Non-mydriatic acquisition:
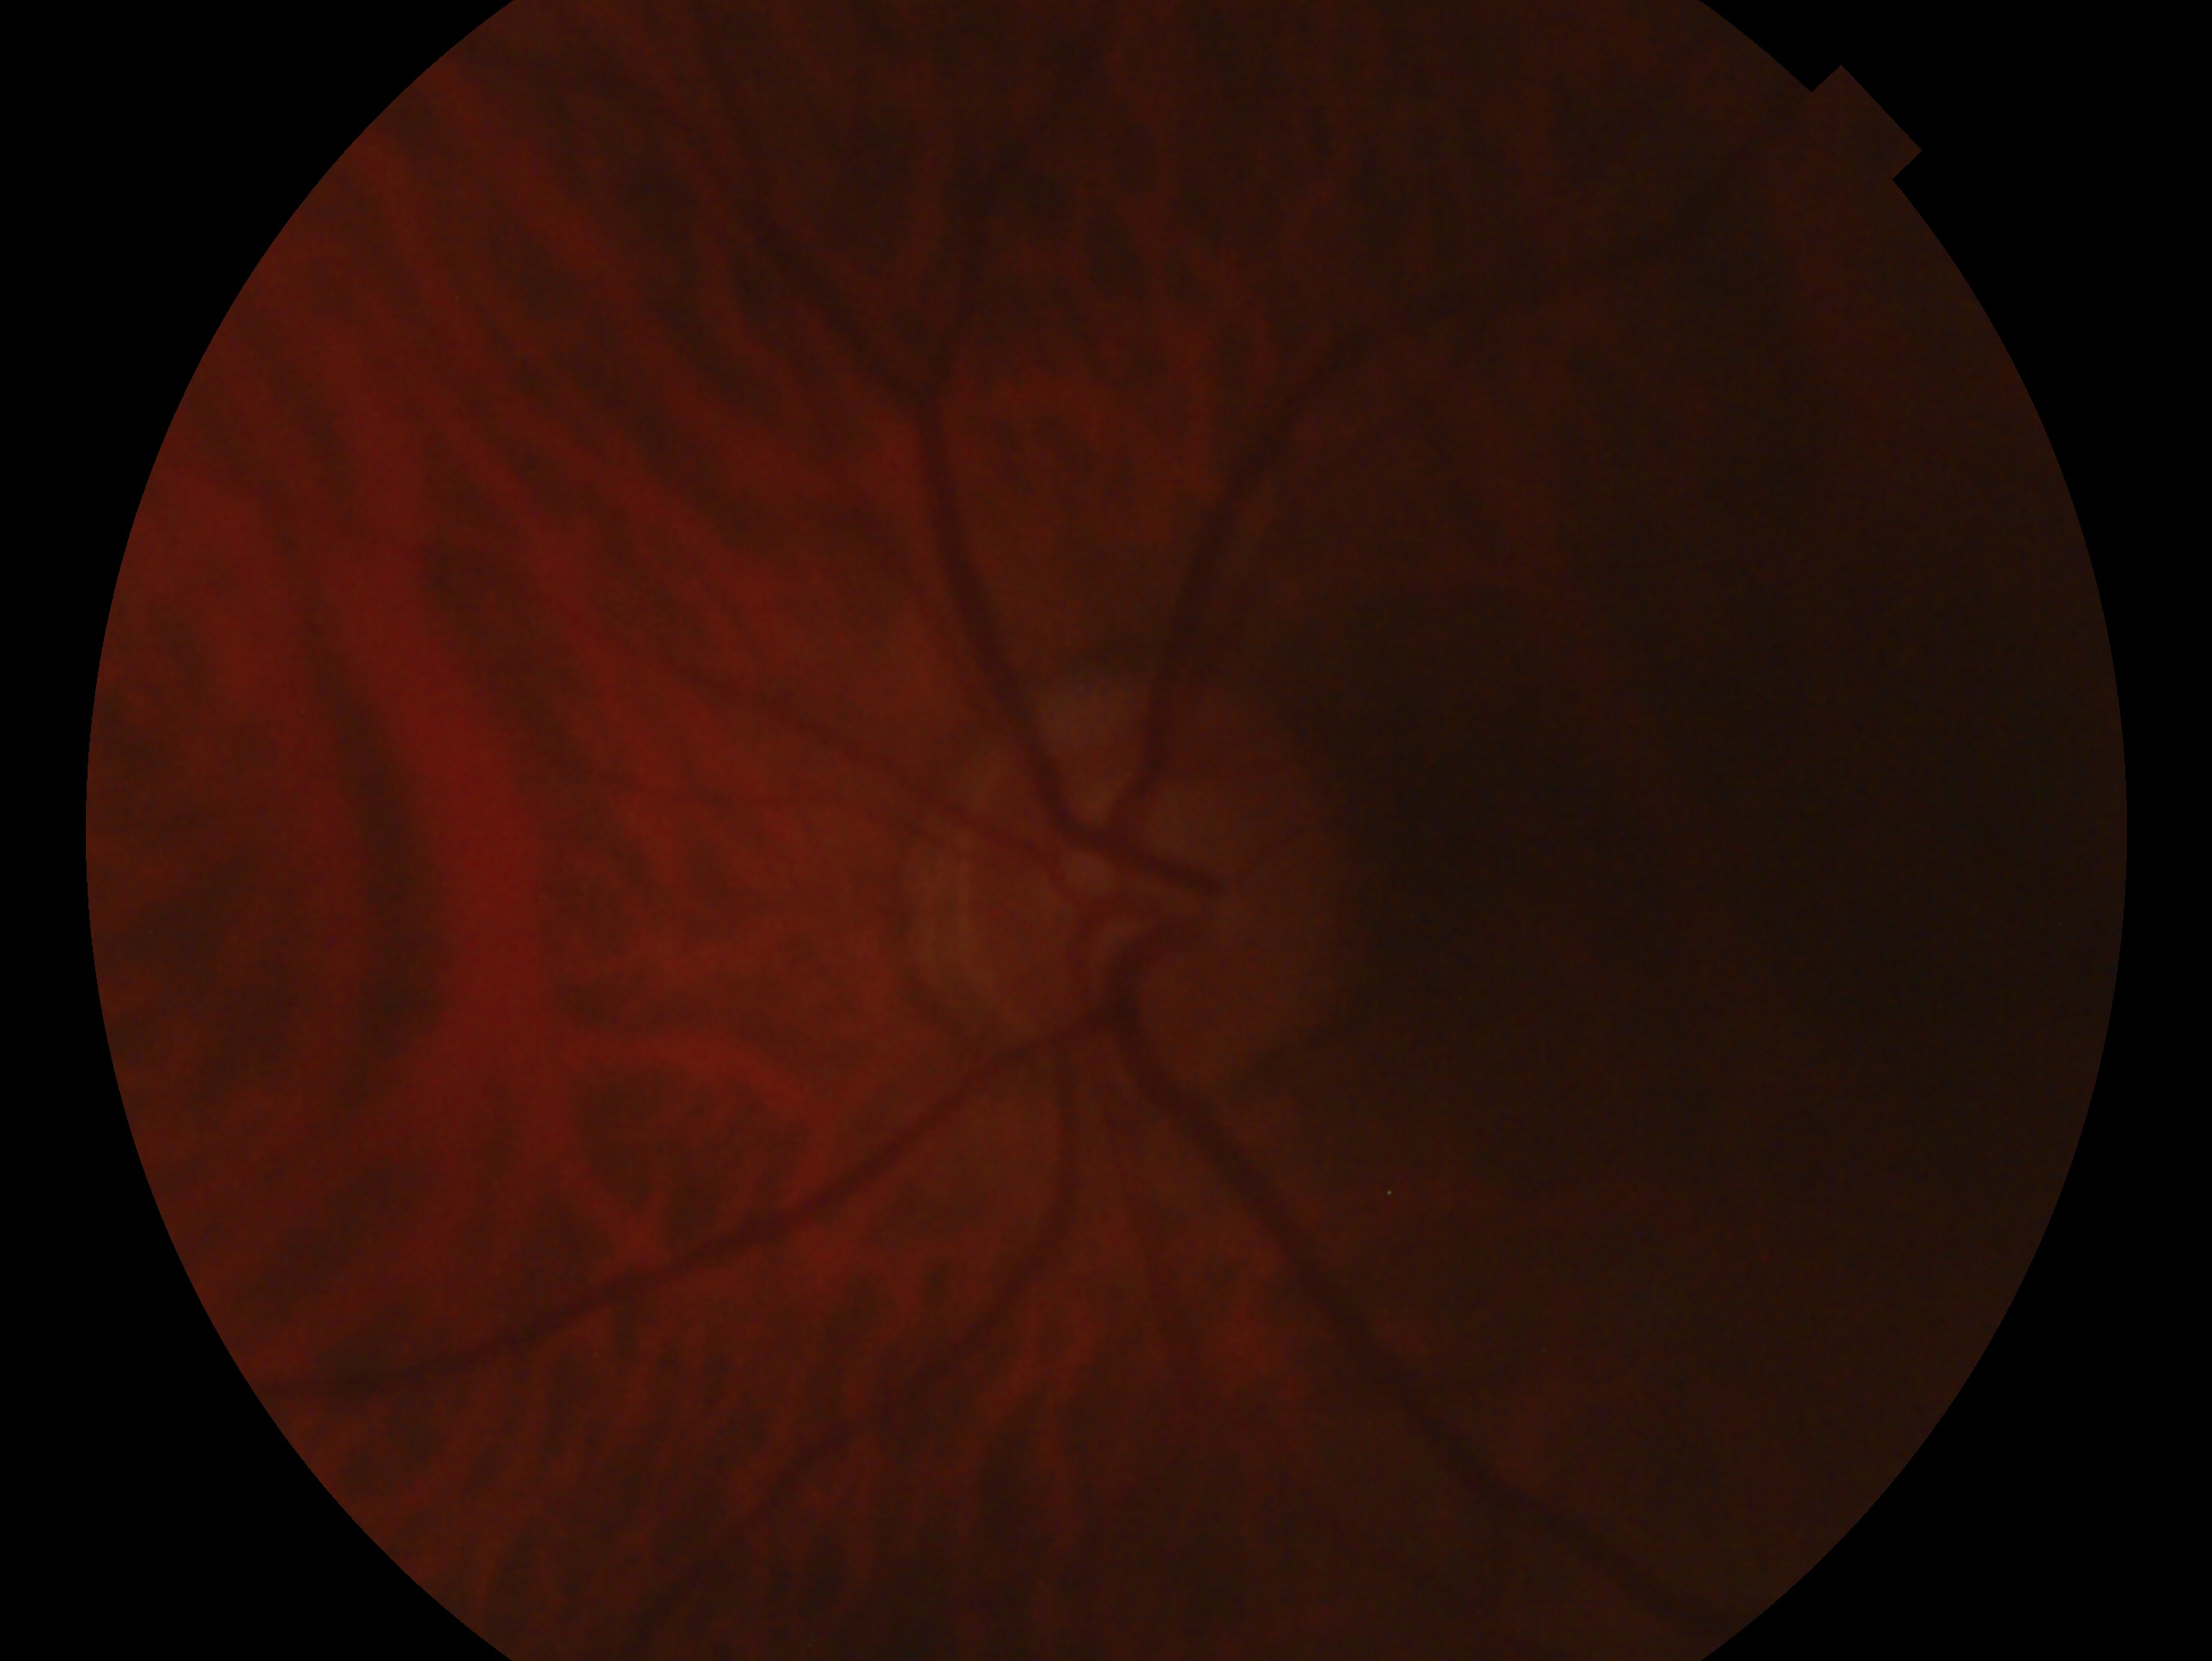
{"eye": "left", "glaucoma_dx": "no evidence of glaucoma"}